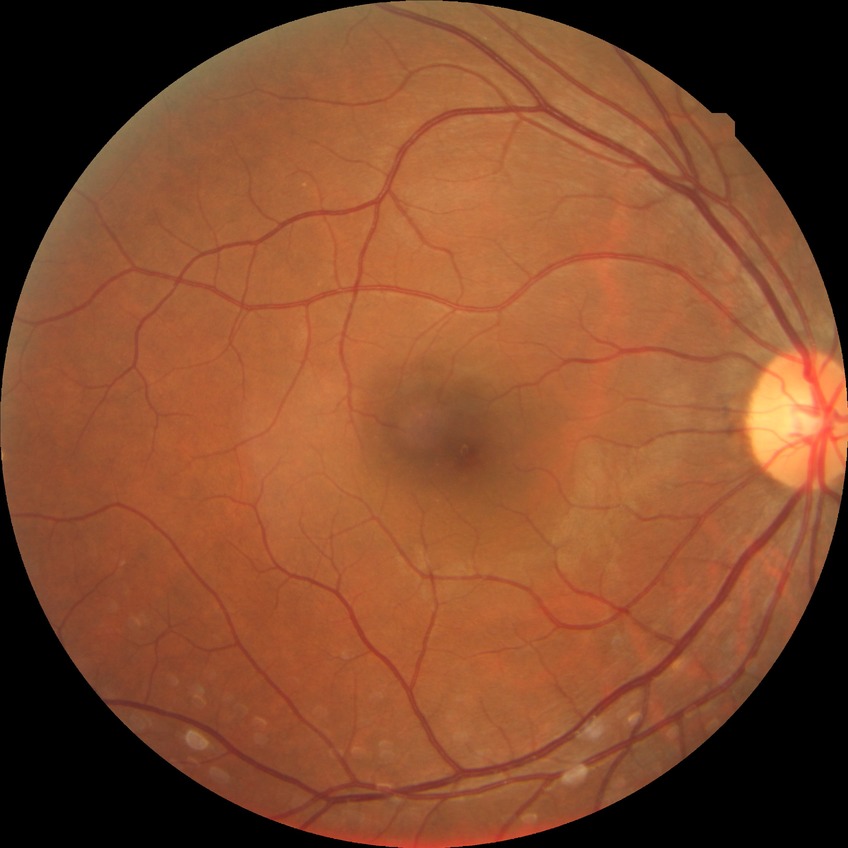
diabetic retinopathy (DR): no diabetic retinopathy (NDR)